Optic nerve head photograph; captured on a Topcon TRC retinal camera:
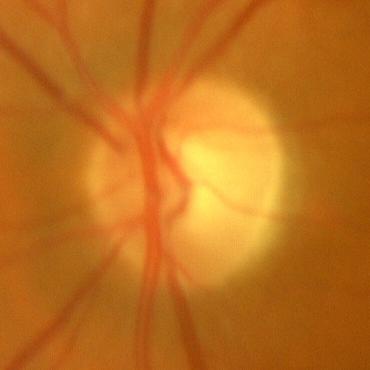

Q: Is glaucoma present?
A: No — no glaucomatous optic neuropathy.